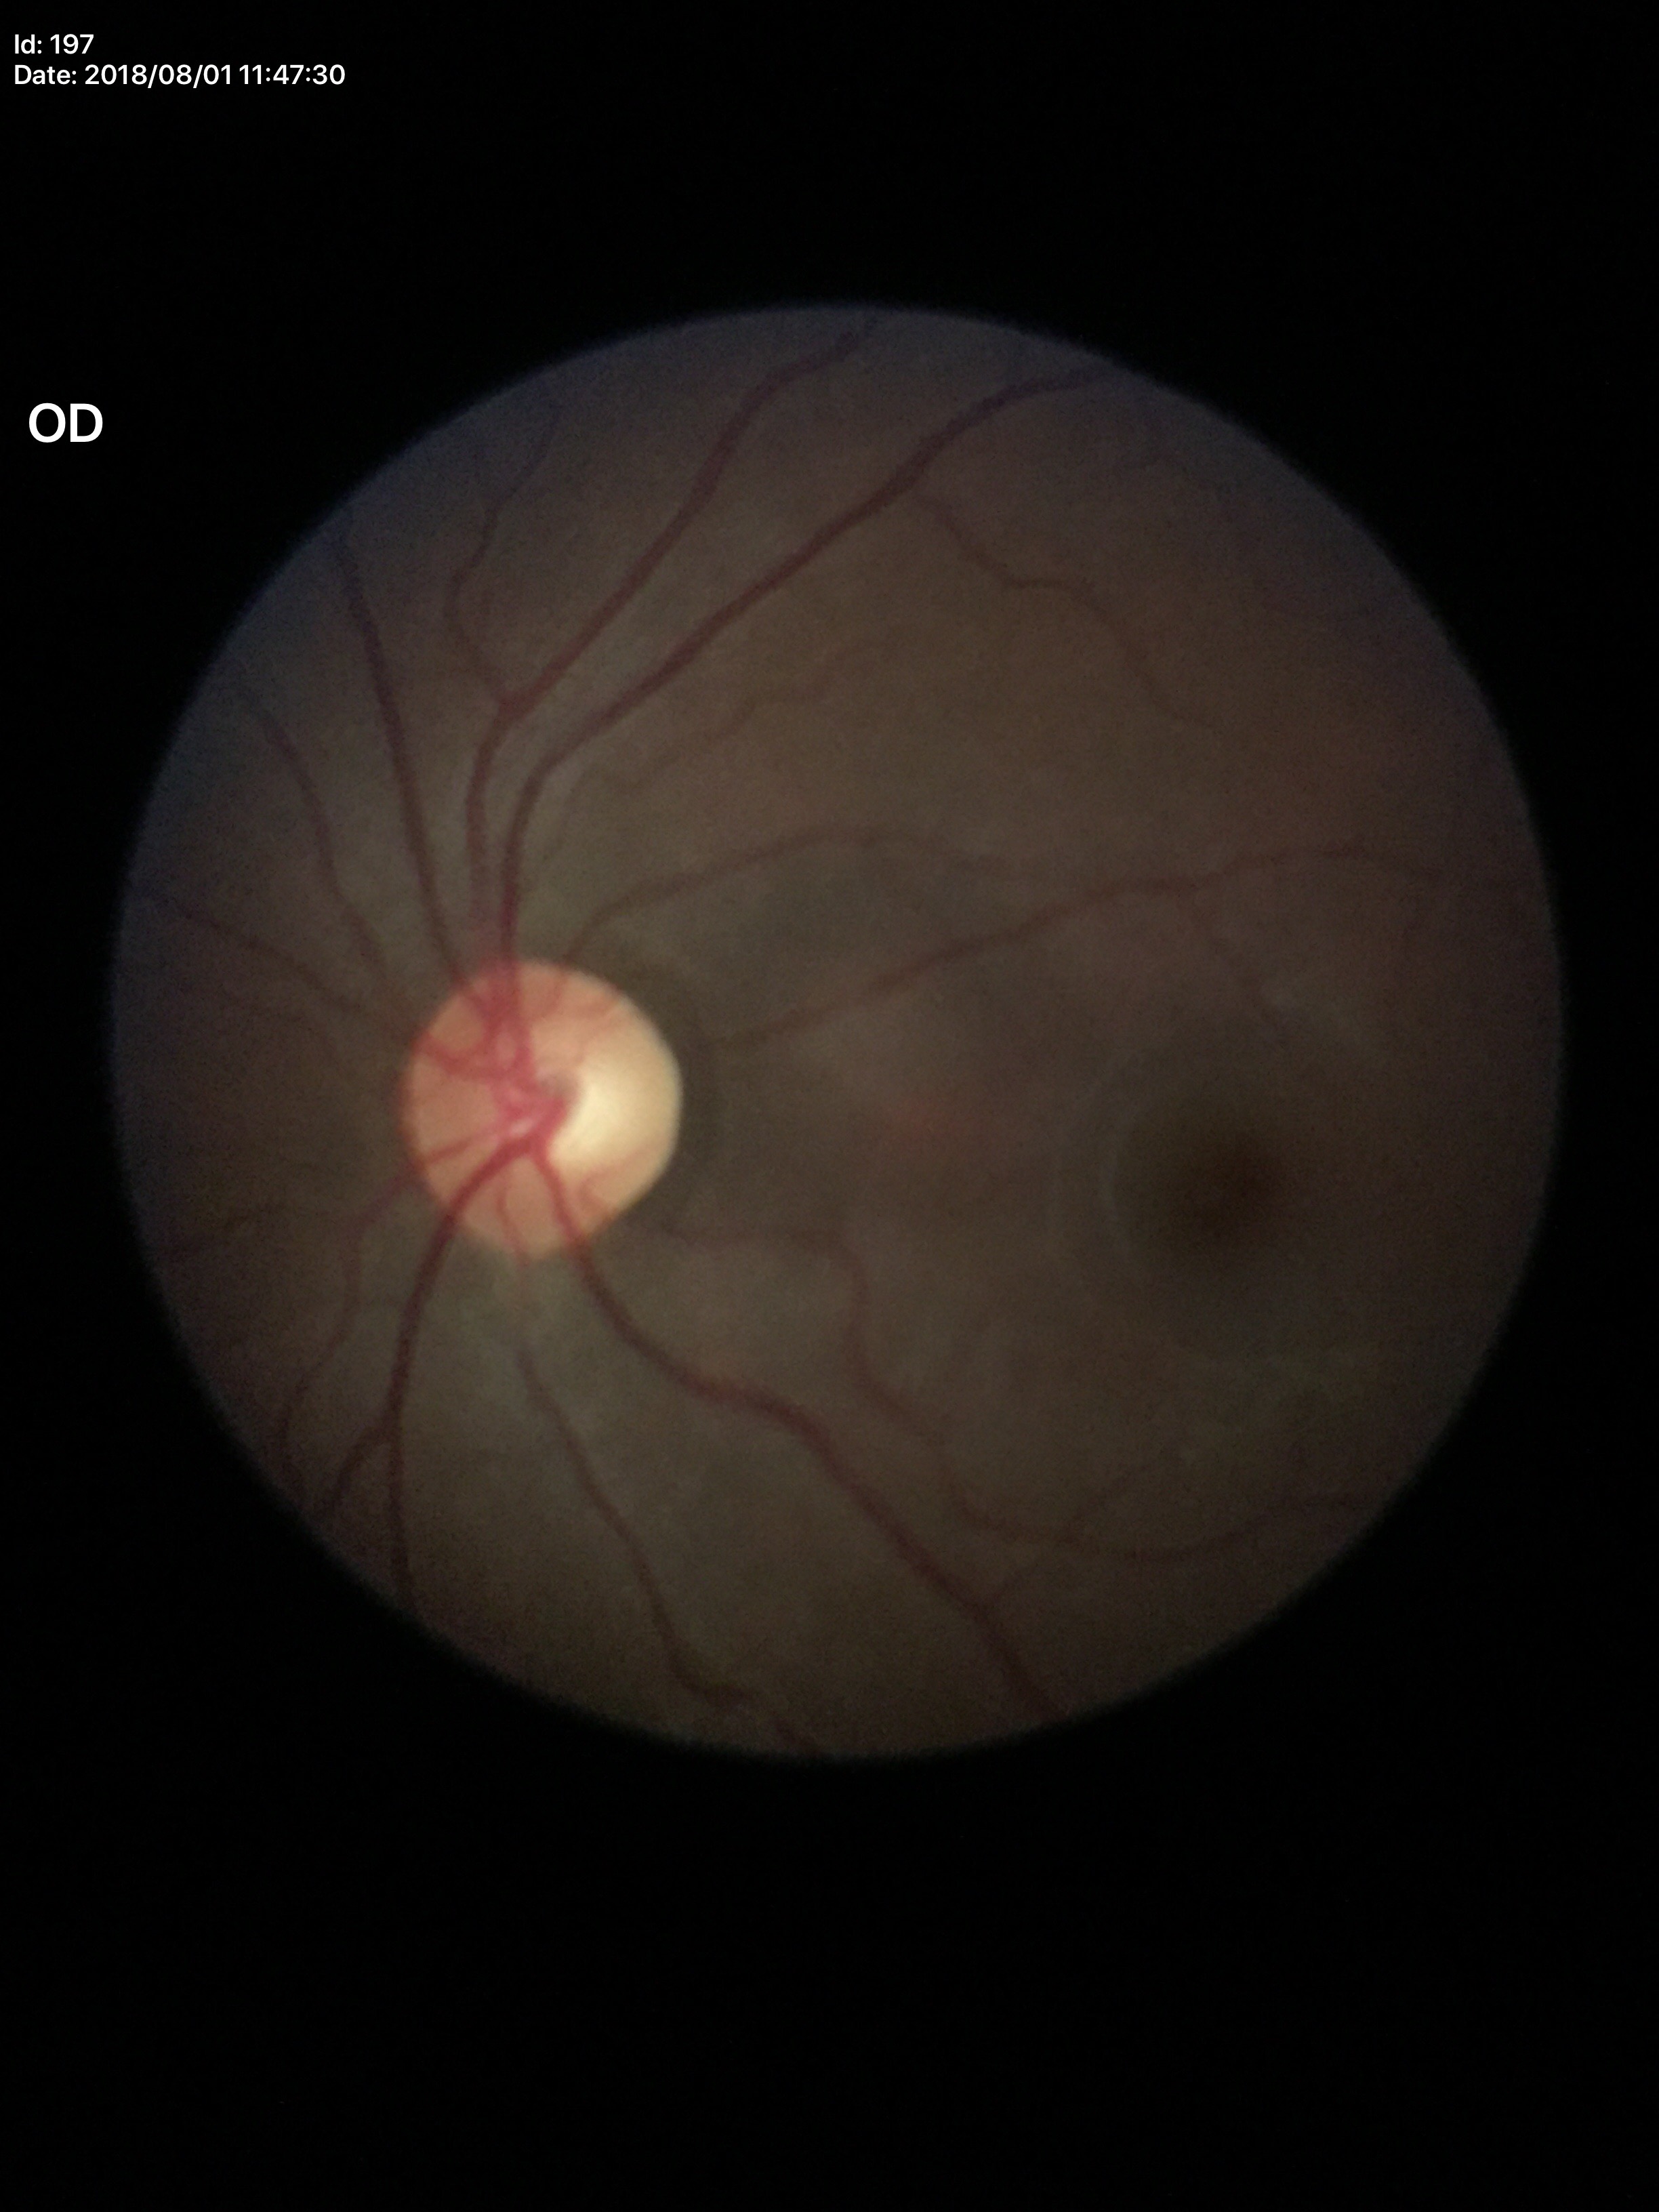

Glaucoma evaluation: not suspect (one of five ophthalmologists flagged glaucoma suspect); horizontal cup-to-disc ratio: 0.59; vertical cup-disc ratio: 0.55.